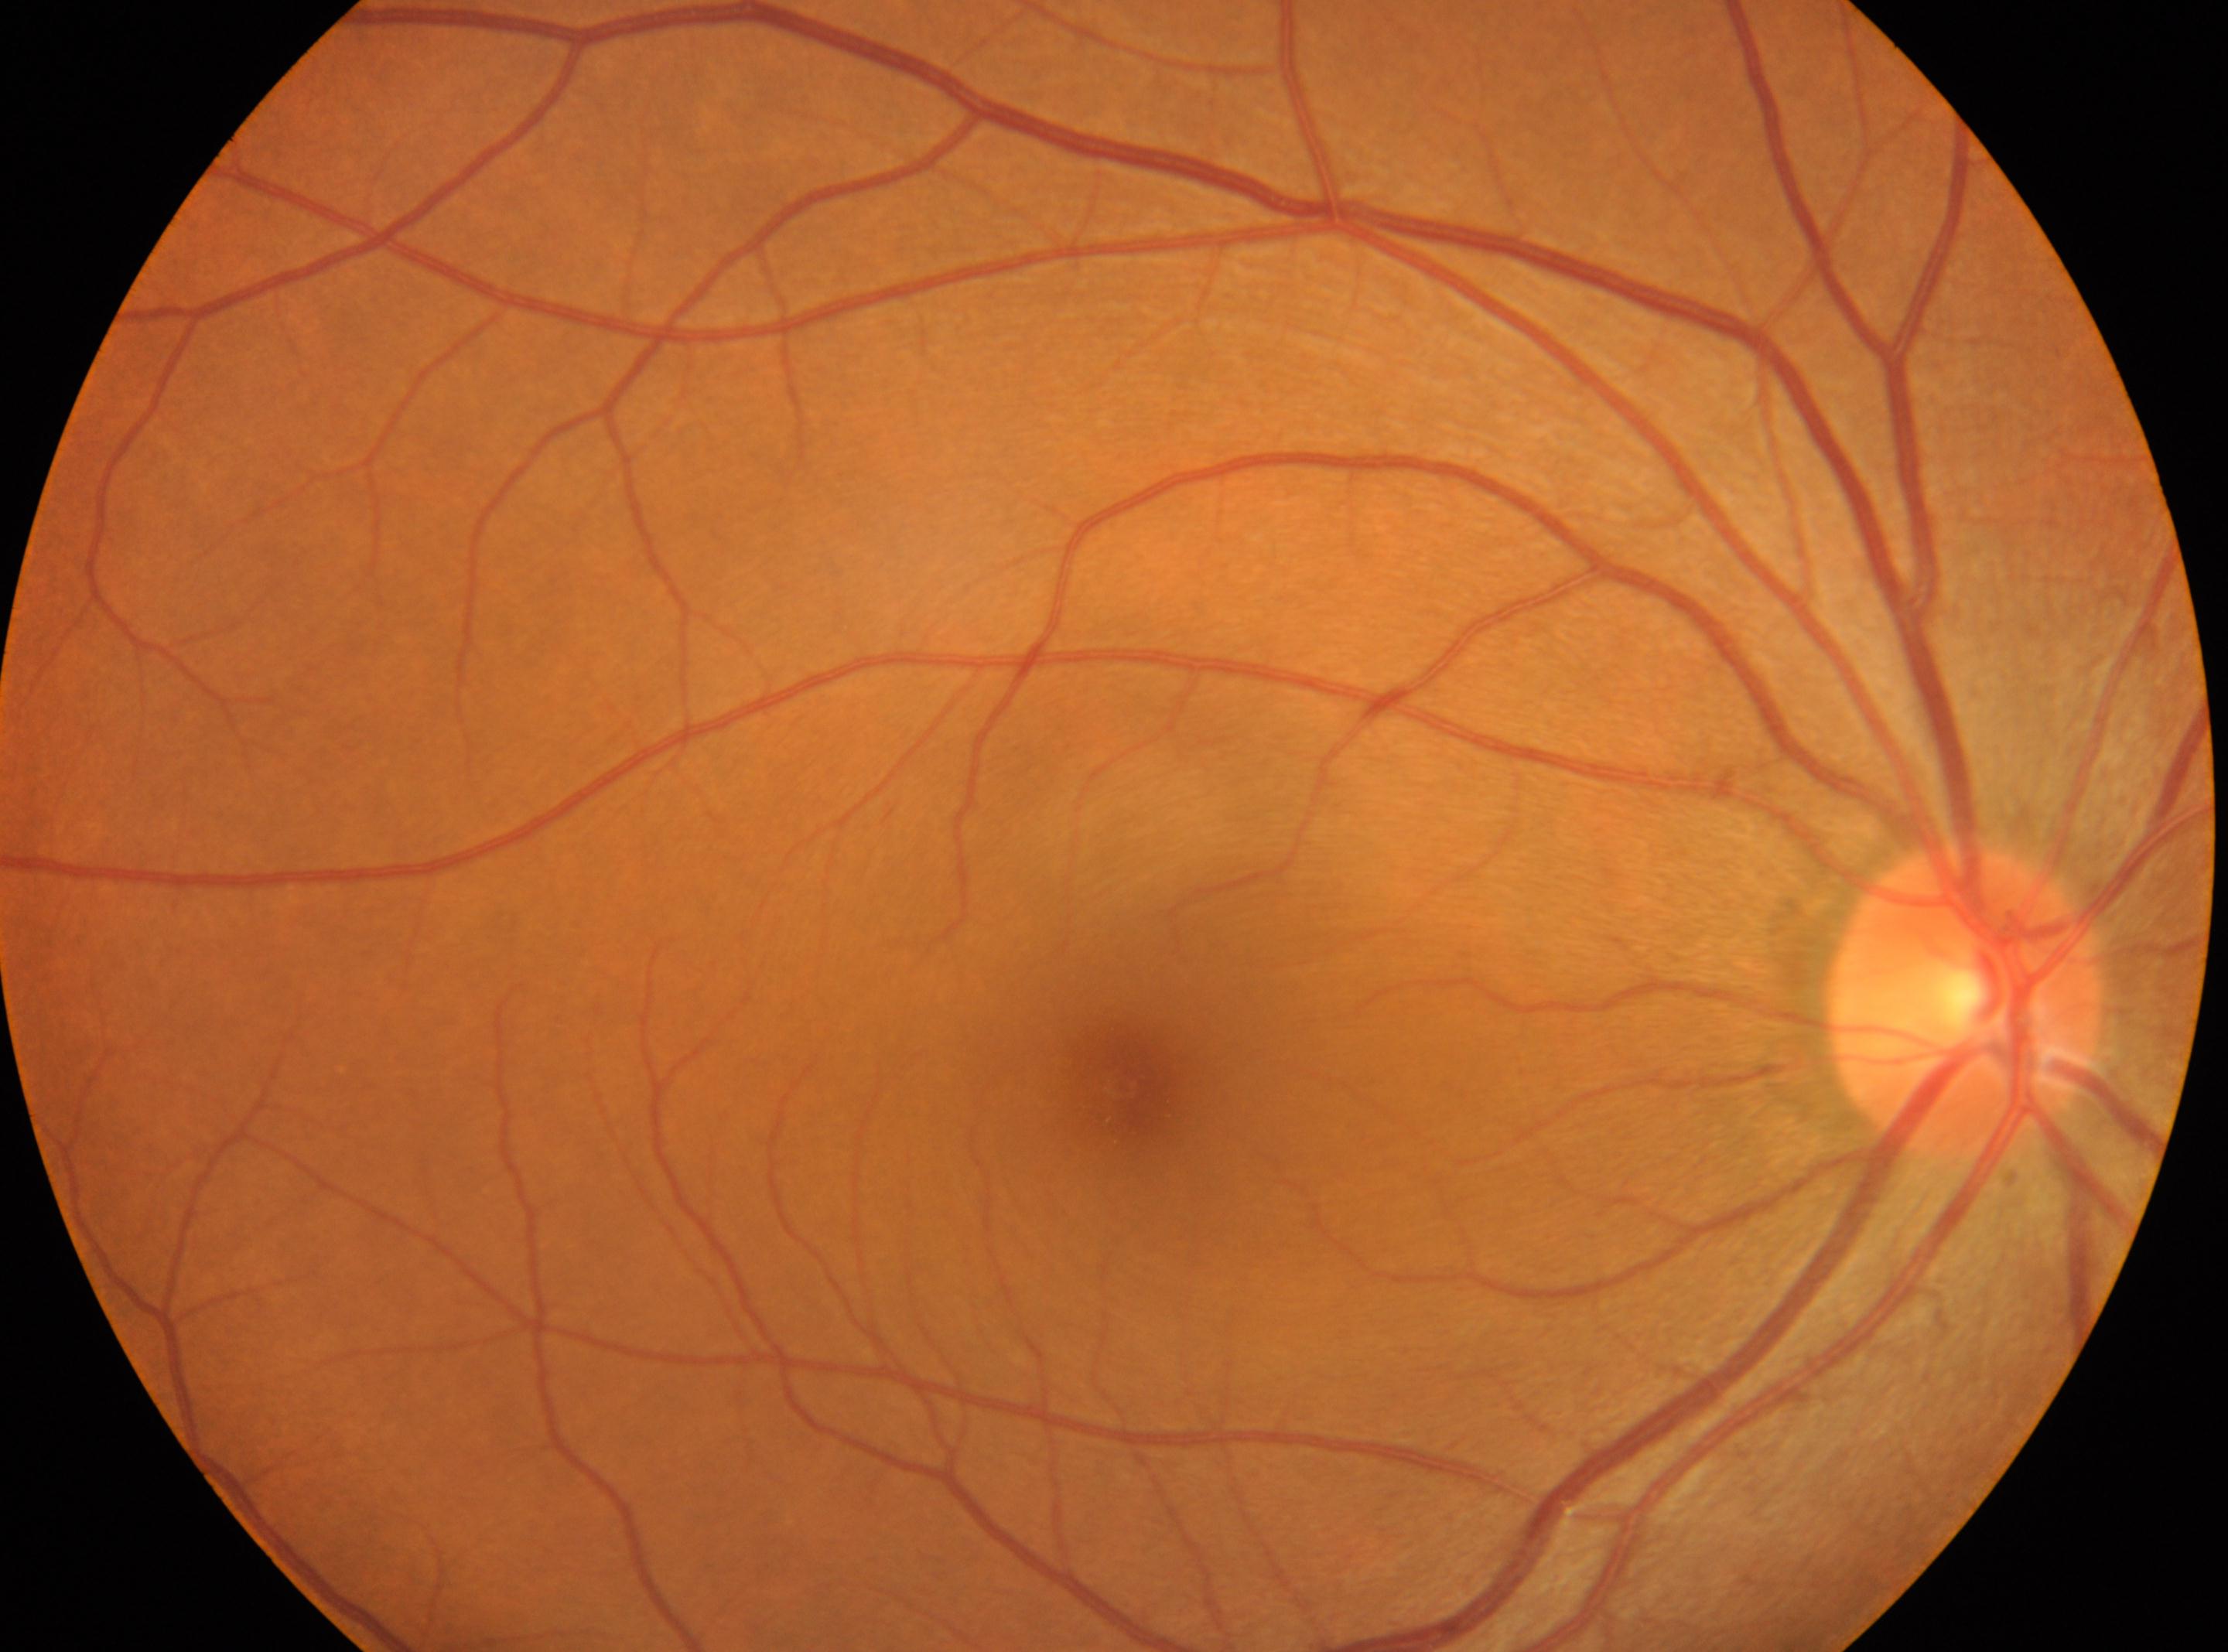

Imaged eye: right eye.
Diabetic retinopathy (DR): grade 0 (no apparent retinopathy).
Fovea center located at [1123, 1089].
The optic nerve head is at [1965, 1000].